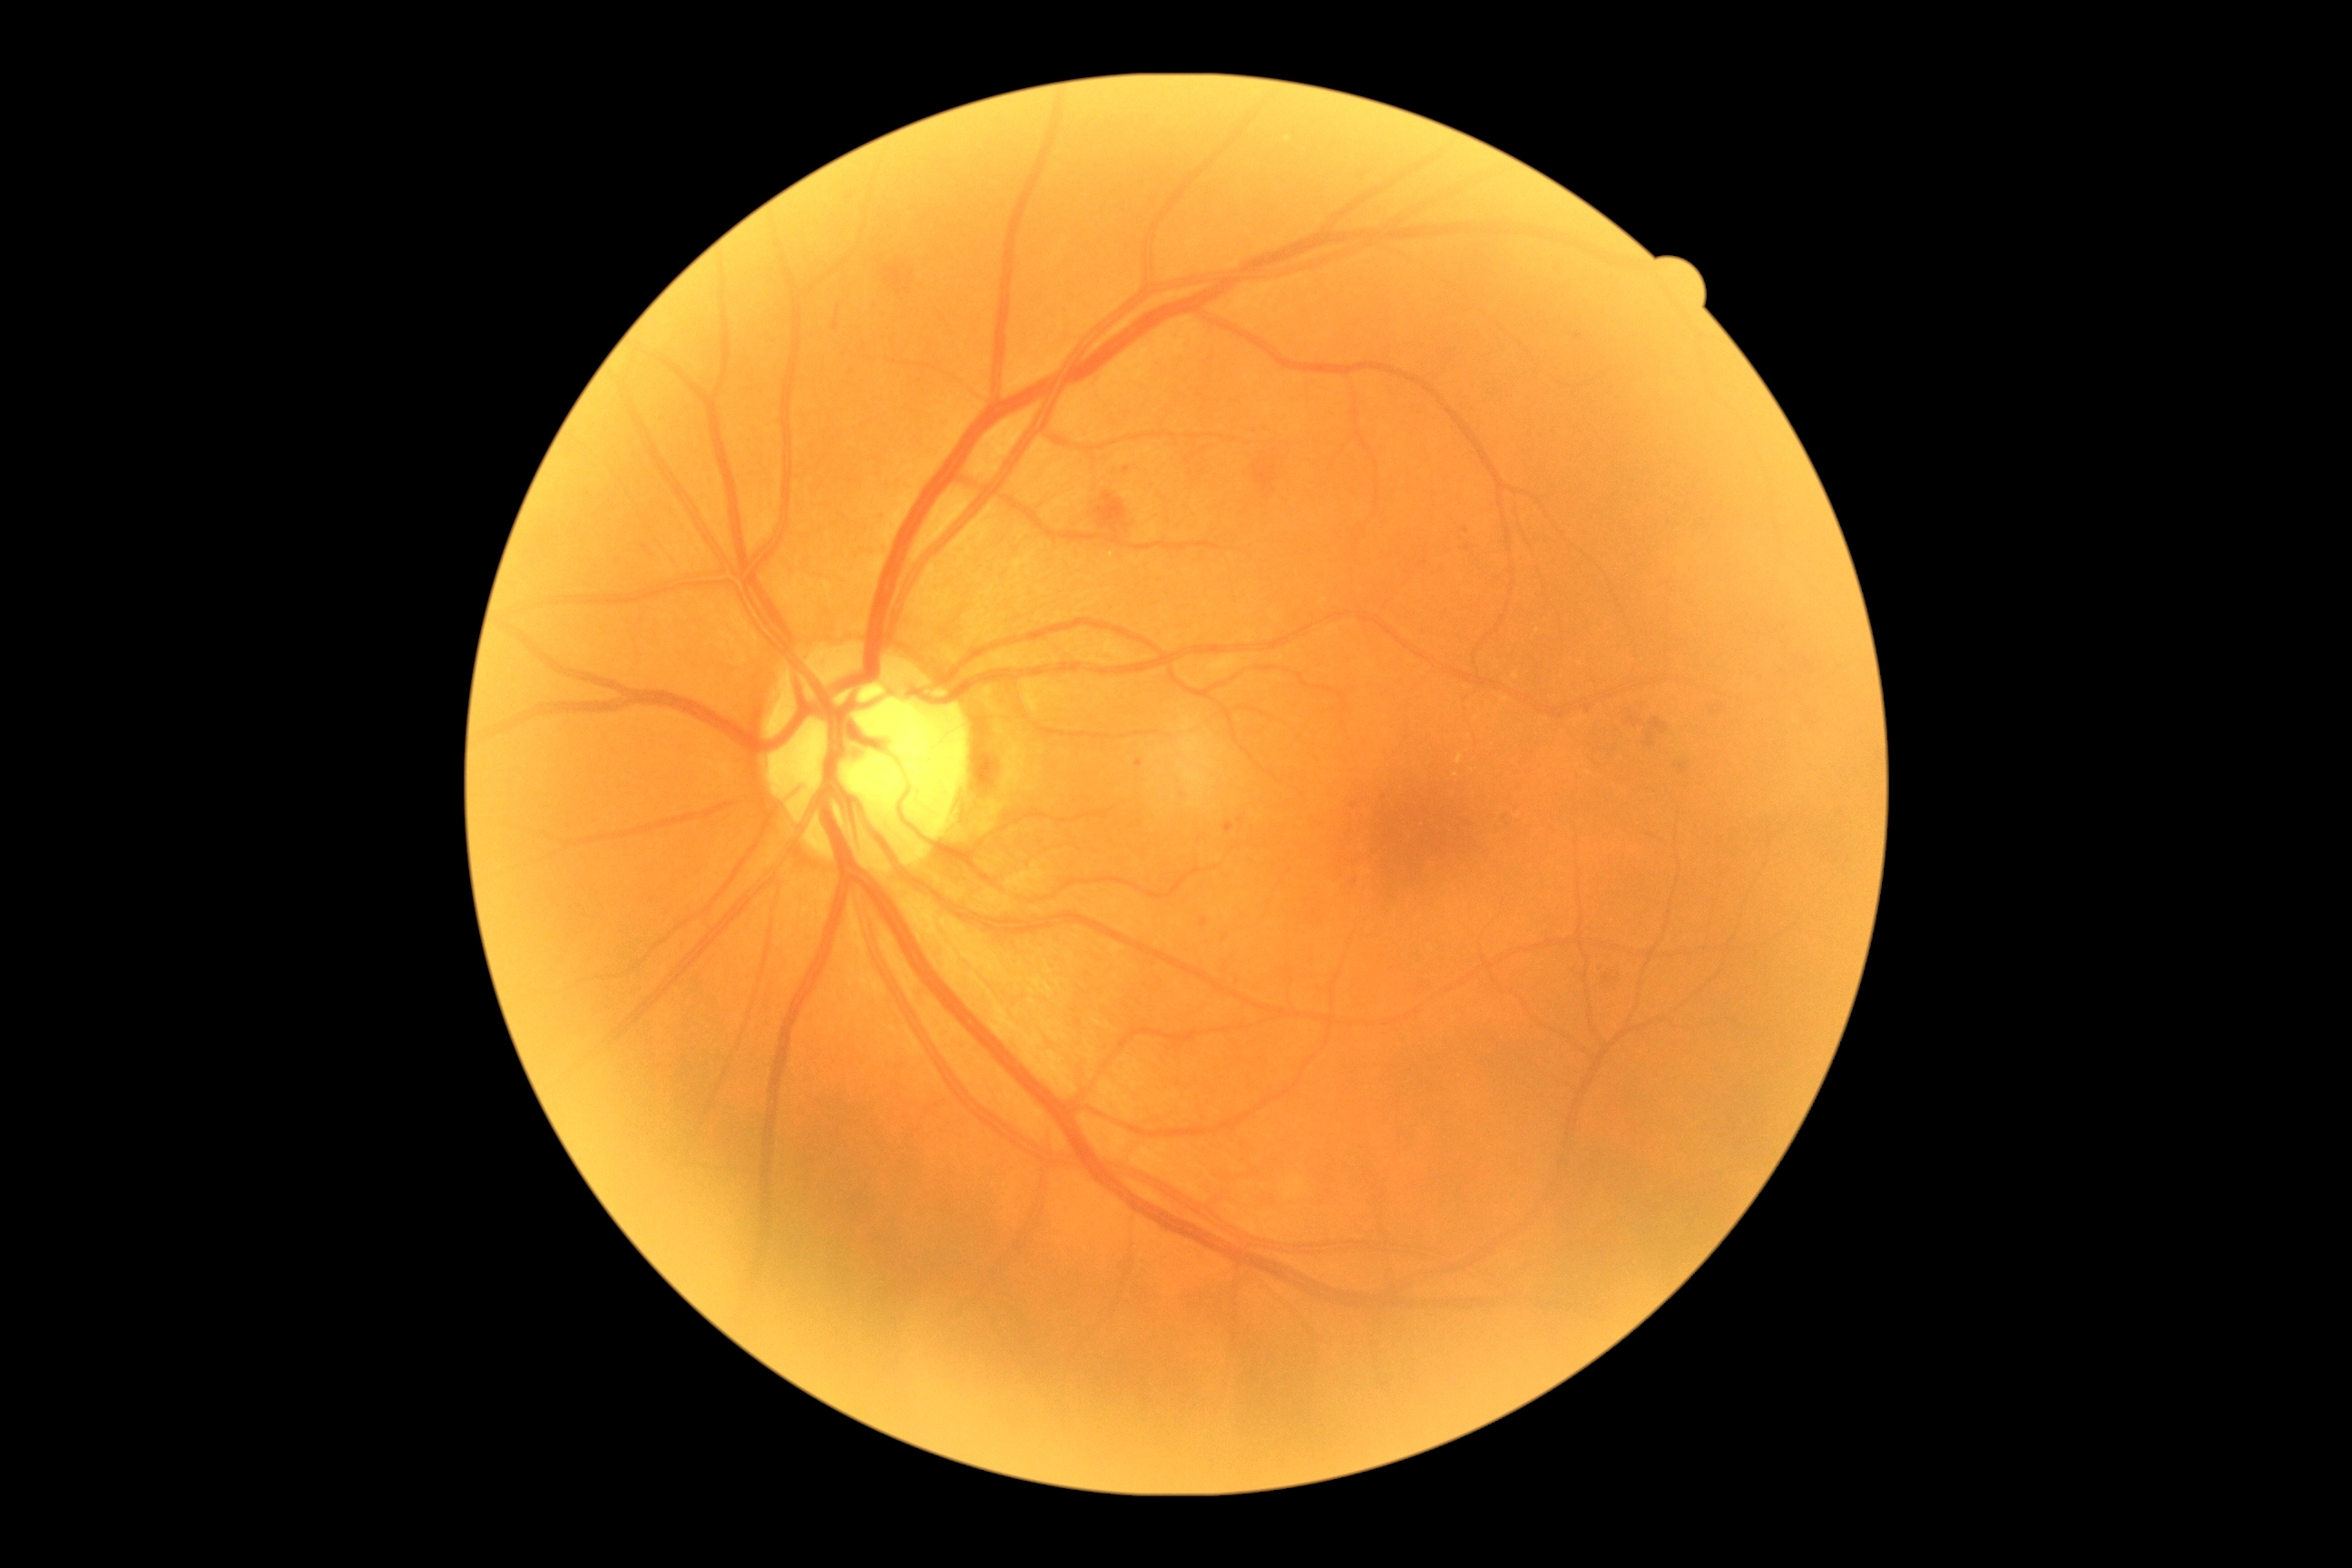

Findings:
* retinopathy: 2